Retinal fundus photograph, 45° field of view
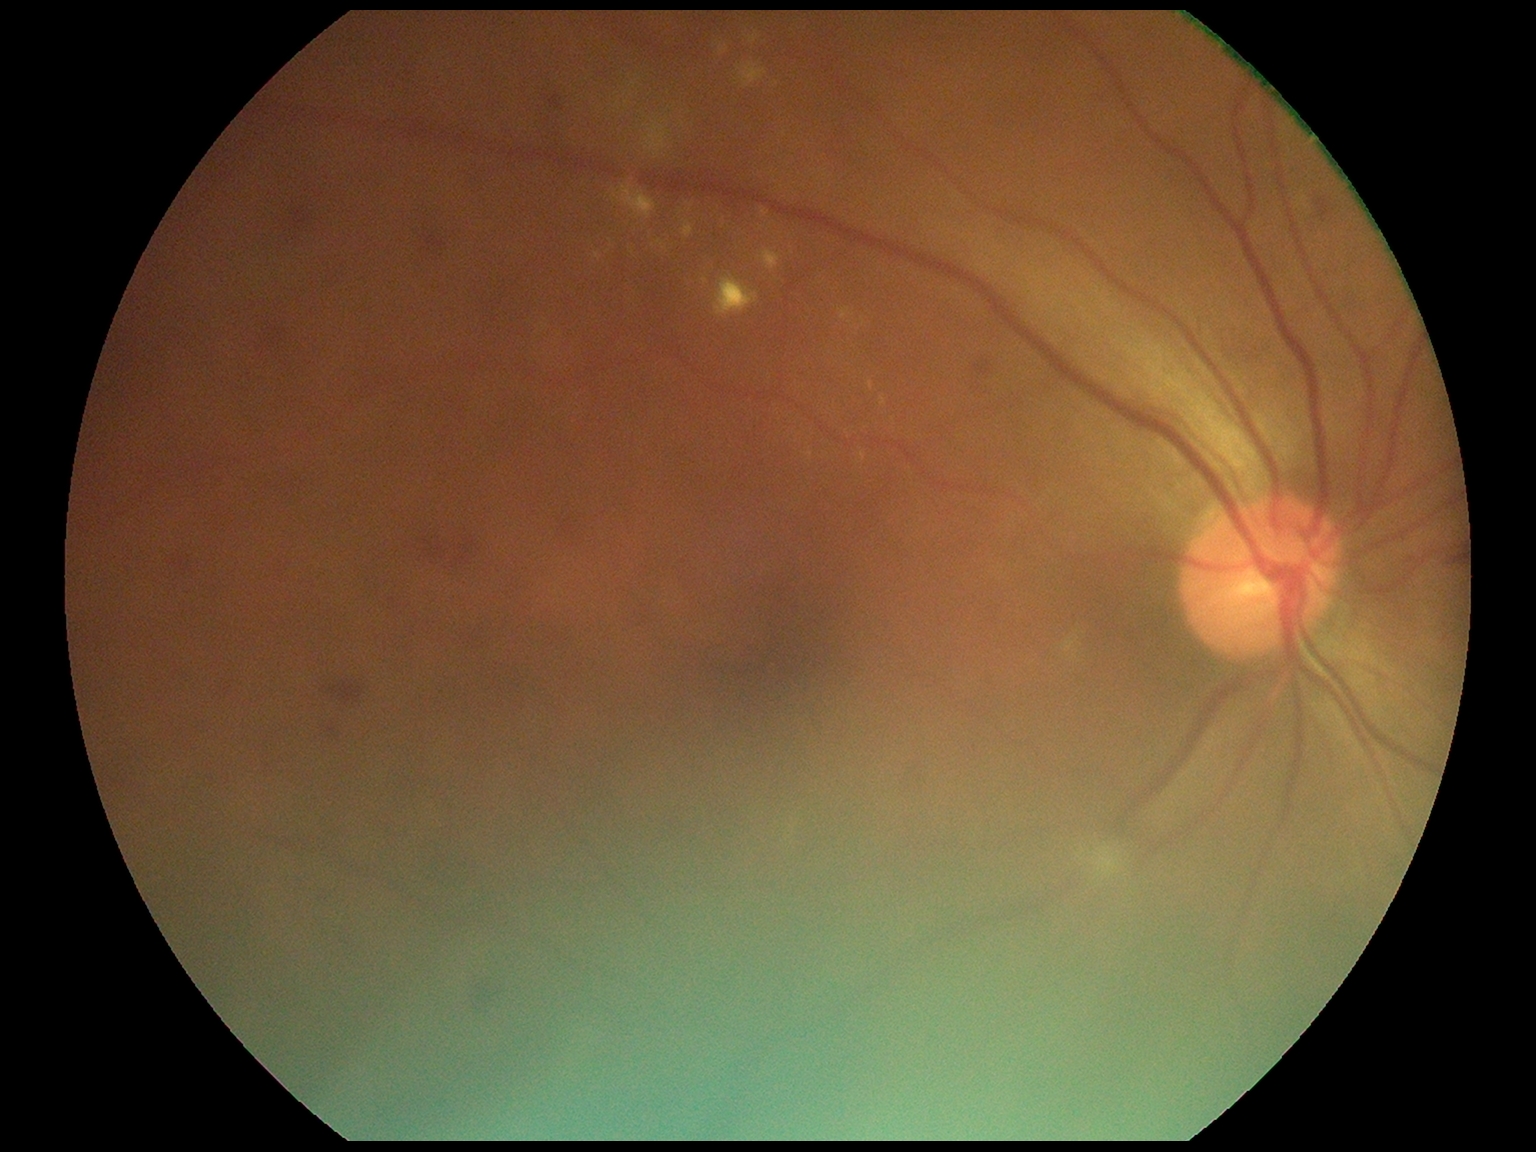
DR: grade 2 (moderate NPDR) — more than just microaneurysms but less than severe NPDR, DR class: non-proliferative diabetic retinopathy.